512x512px. Retinal fundus photograph — 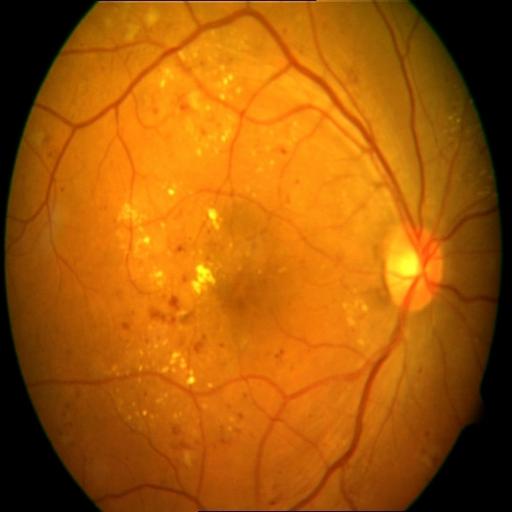 Findings (2): hemorrhagic retinopathy; exudation.